Fundus photo
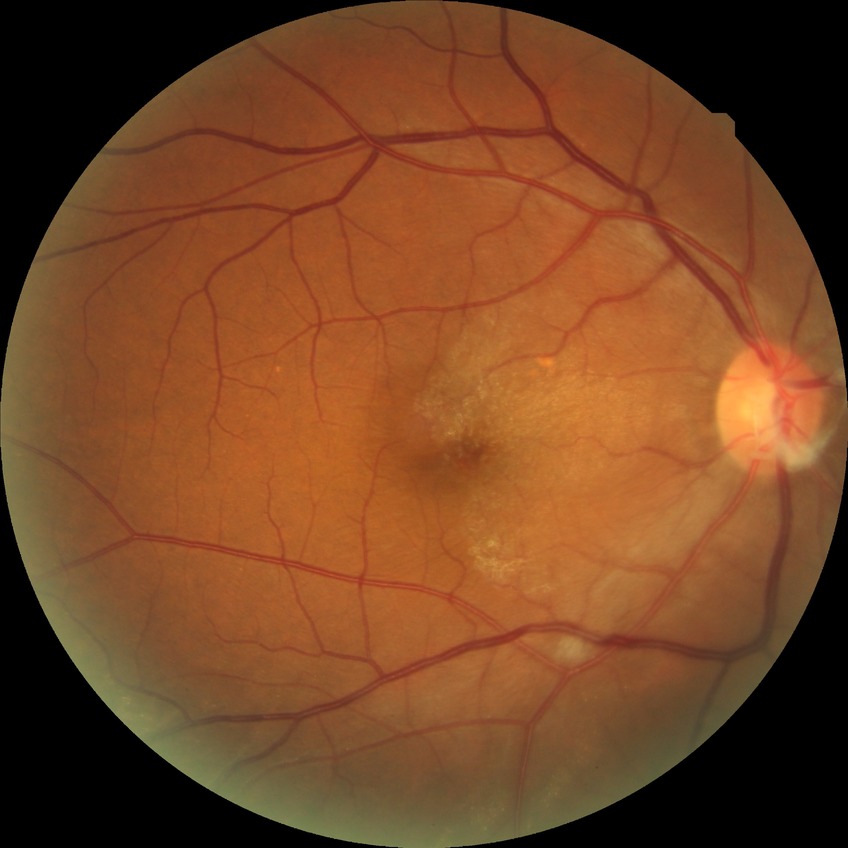

Modified Davis grading: no diabetic retinopathy.